Retinal fundus photograph; without pupil dilation; 848 x 848 pixels; Davis DR grading — 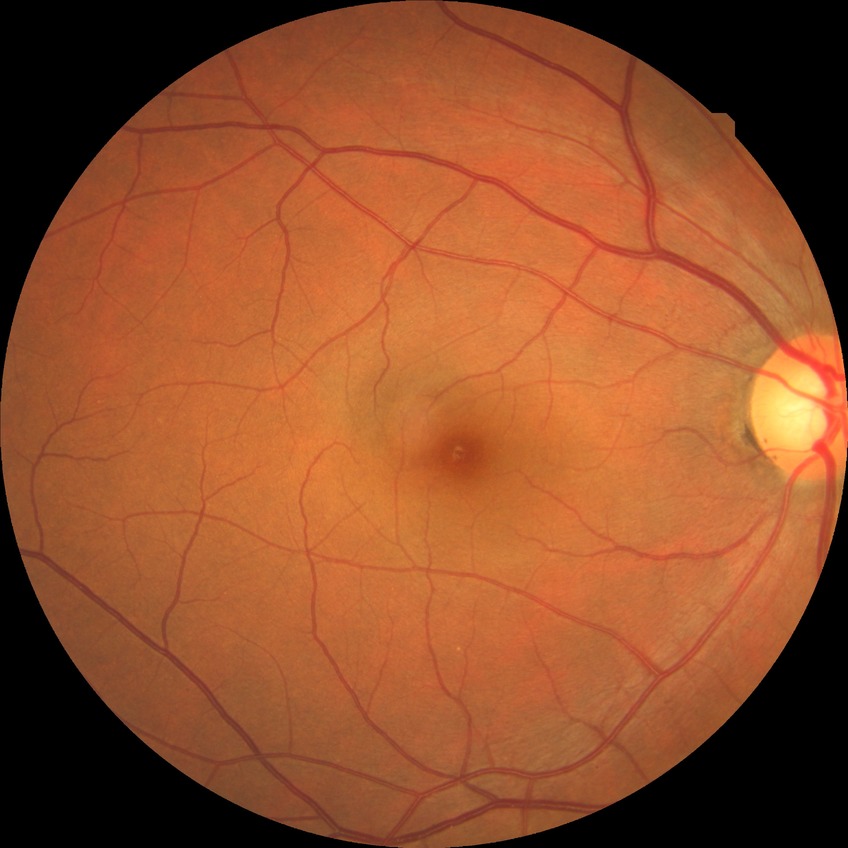

Diabetic retinopathy (DR): NDR (no diabetic retinopathy).